CFP — 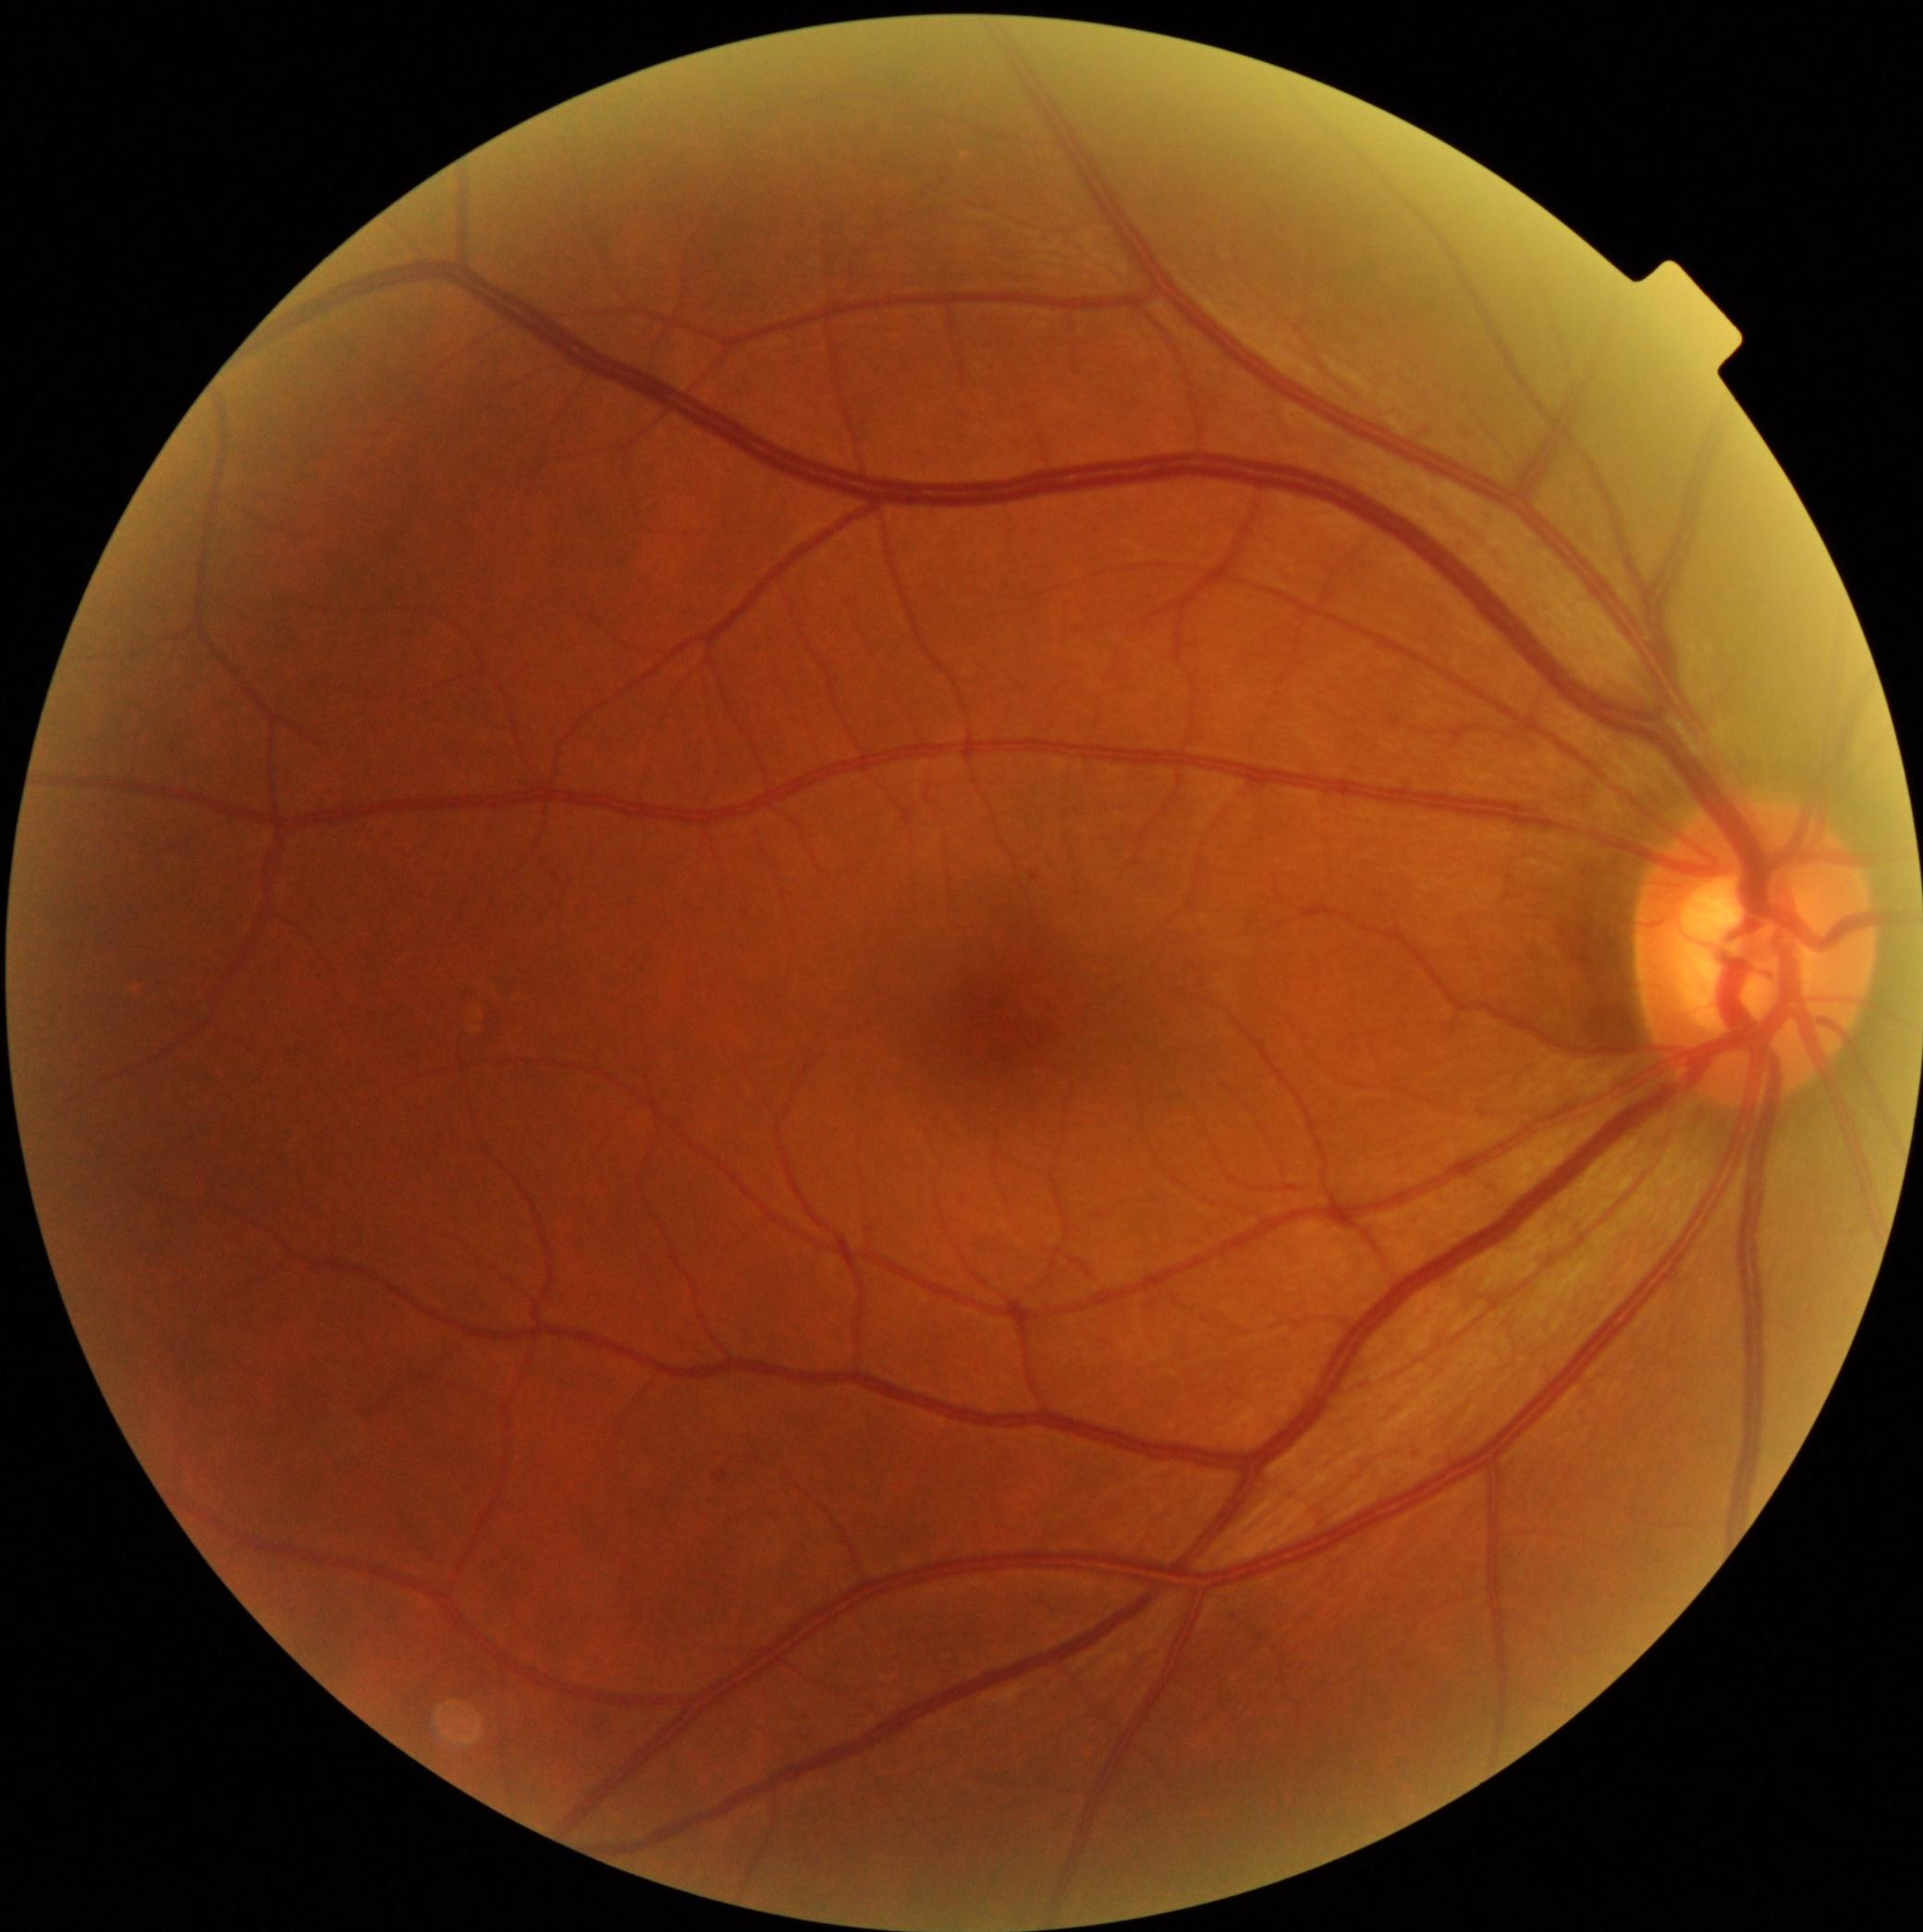 Annotations:
* diabetic retinopathy (DR): grade 2 — more than just microaneurysms but less than severe NPDR